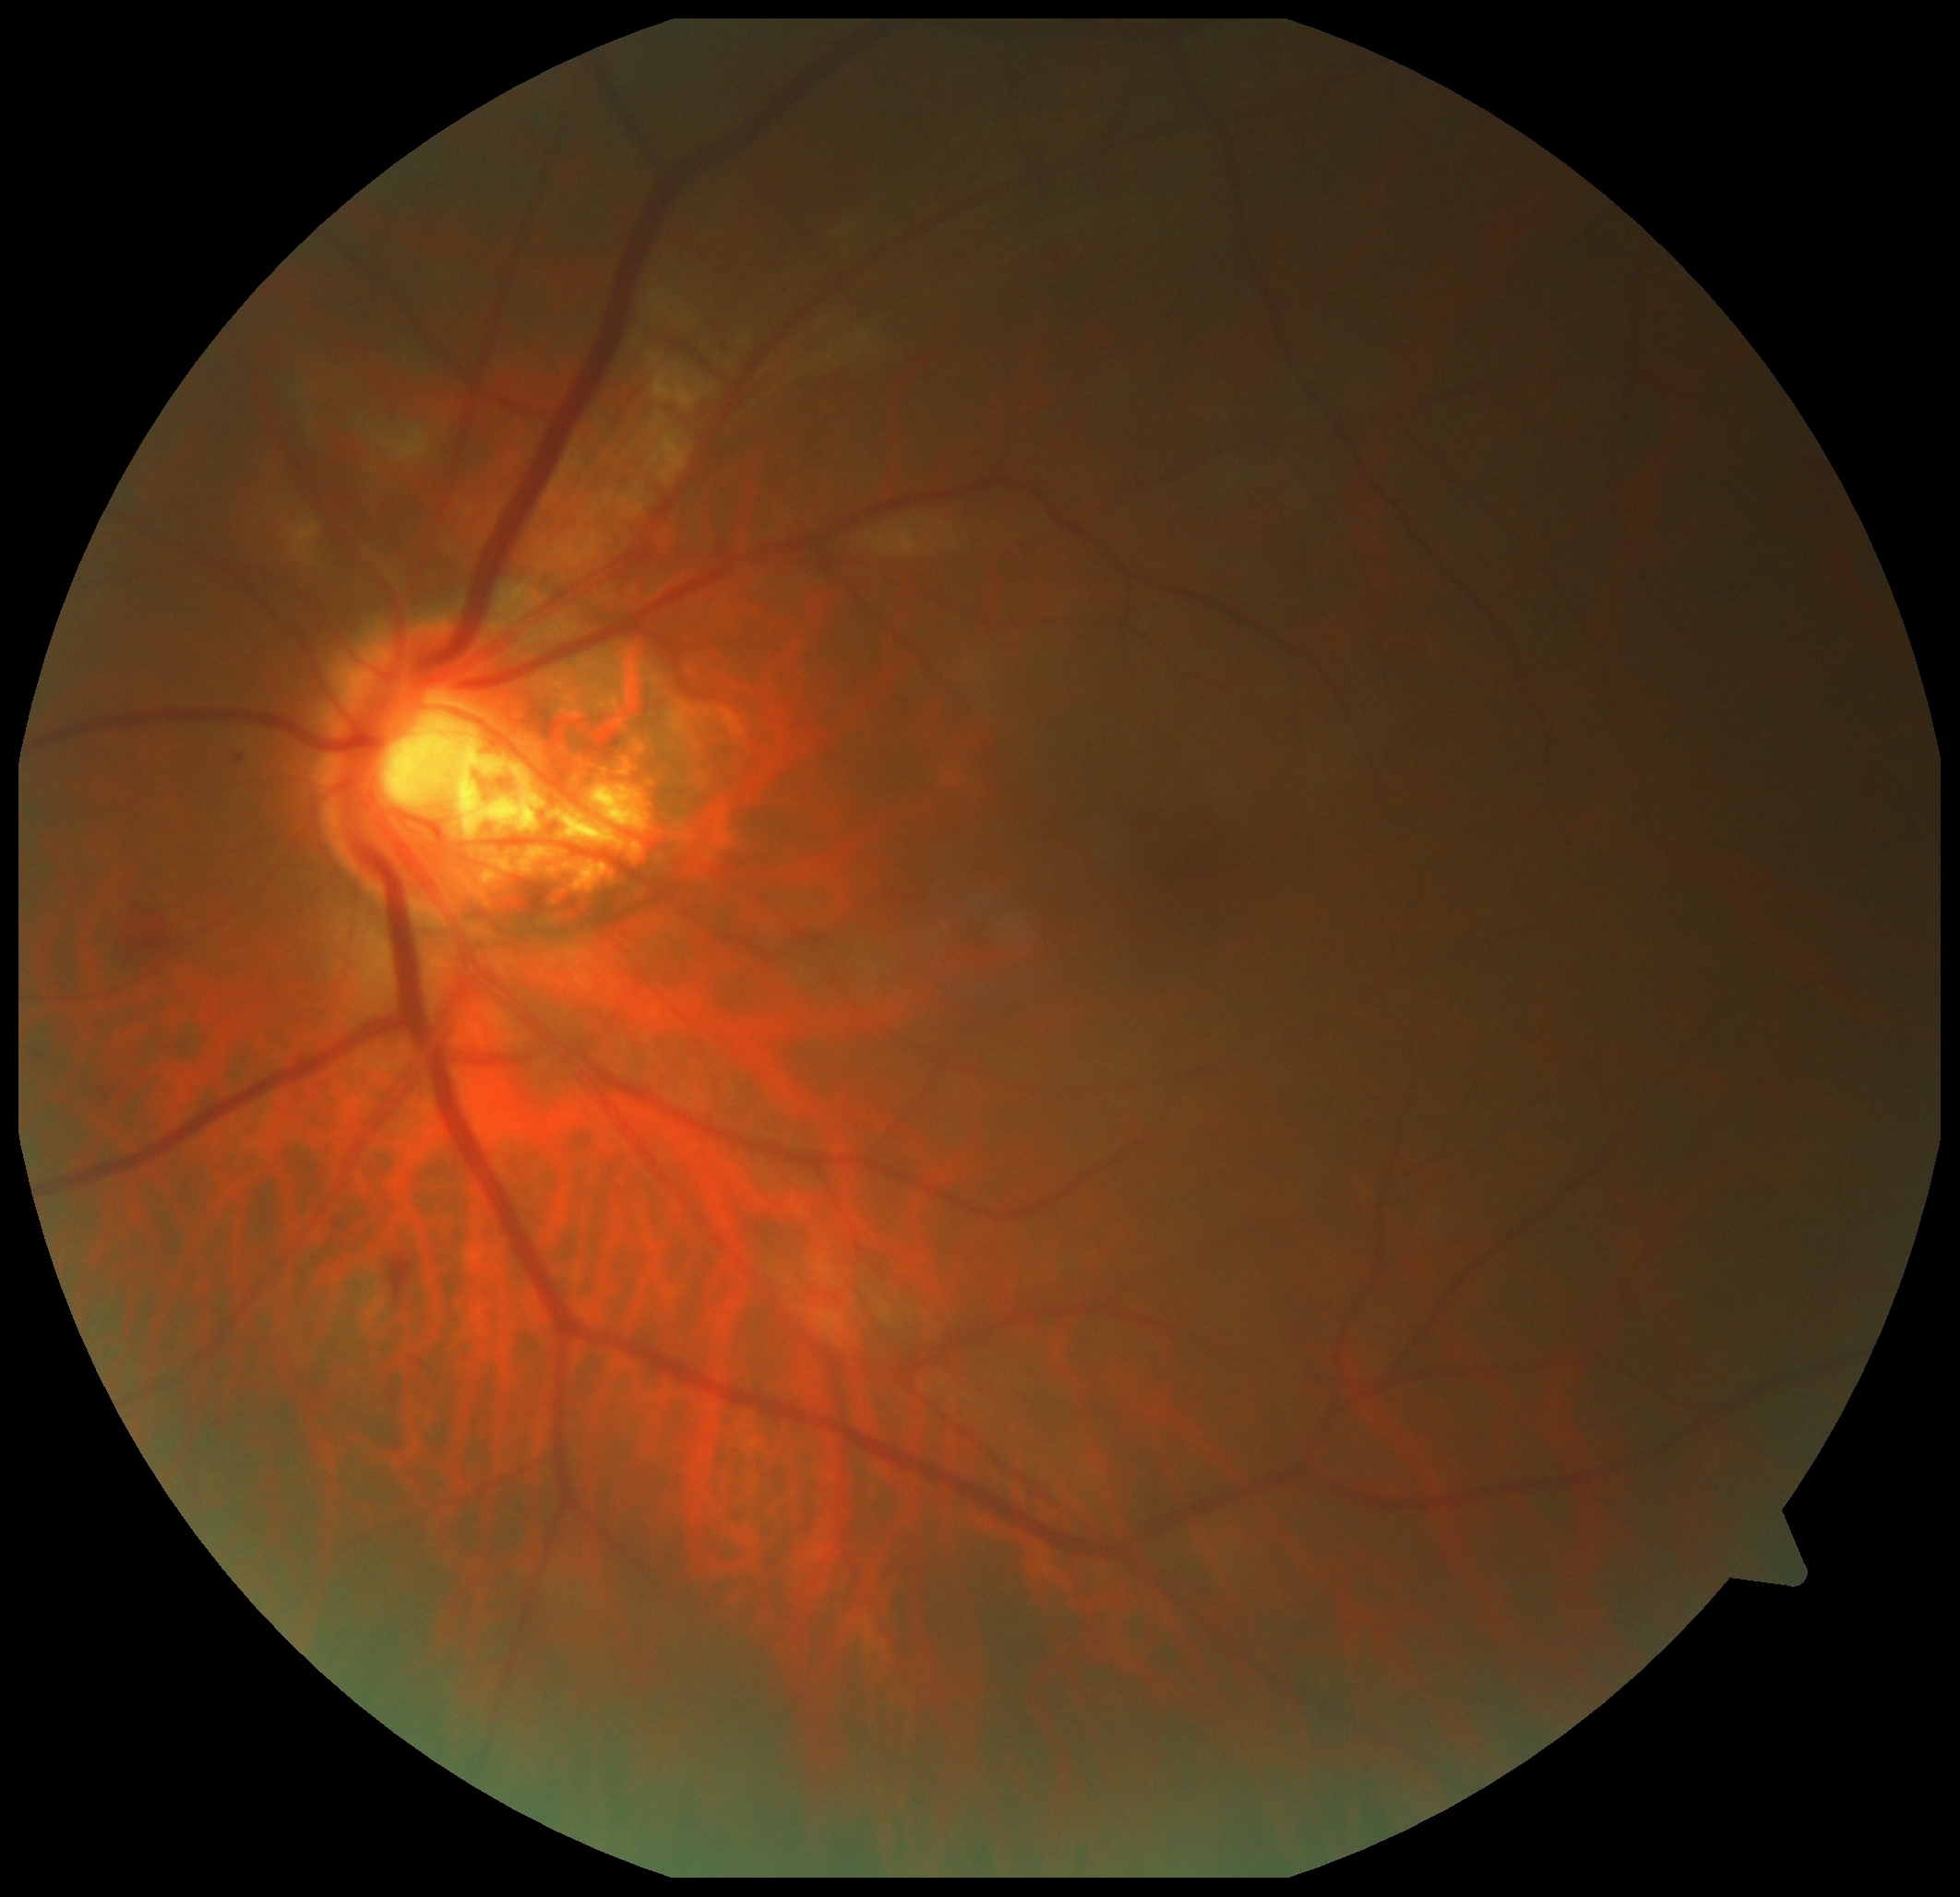

DR: 2/4 — more than just microaneurysms but less than severe NPDR.